1240 by 1240 pixels. Infant wide-field fundus photograph — 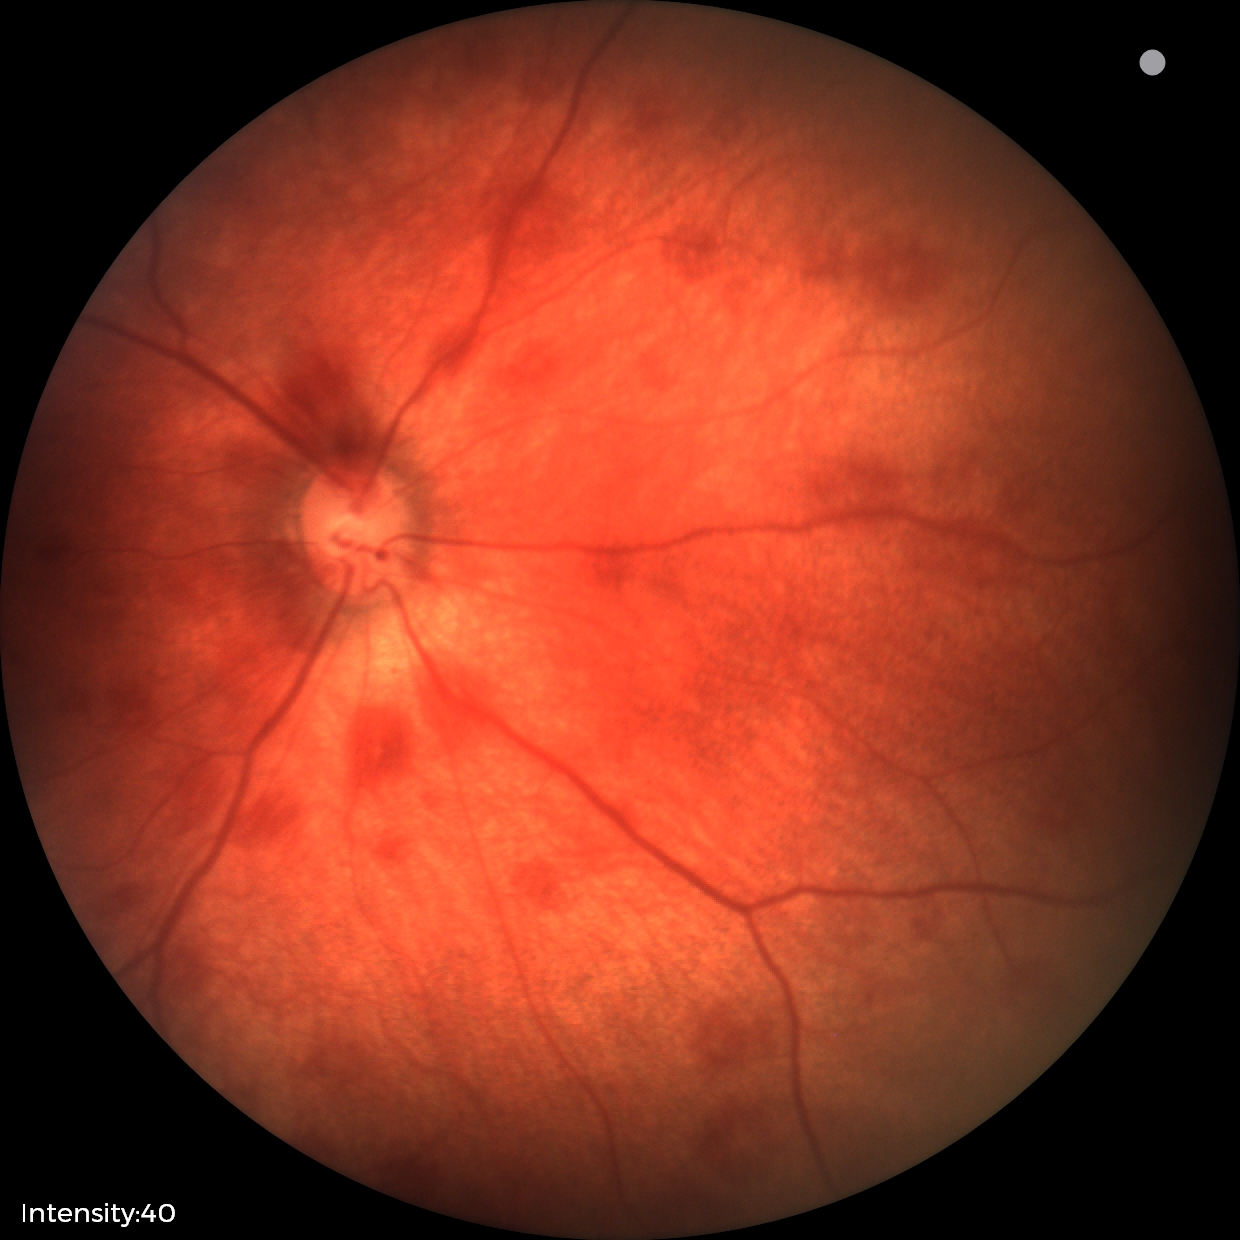

Diagnosis from this screening exam: retinal hemorrhages.